2352x1568px.
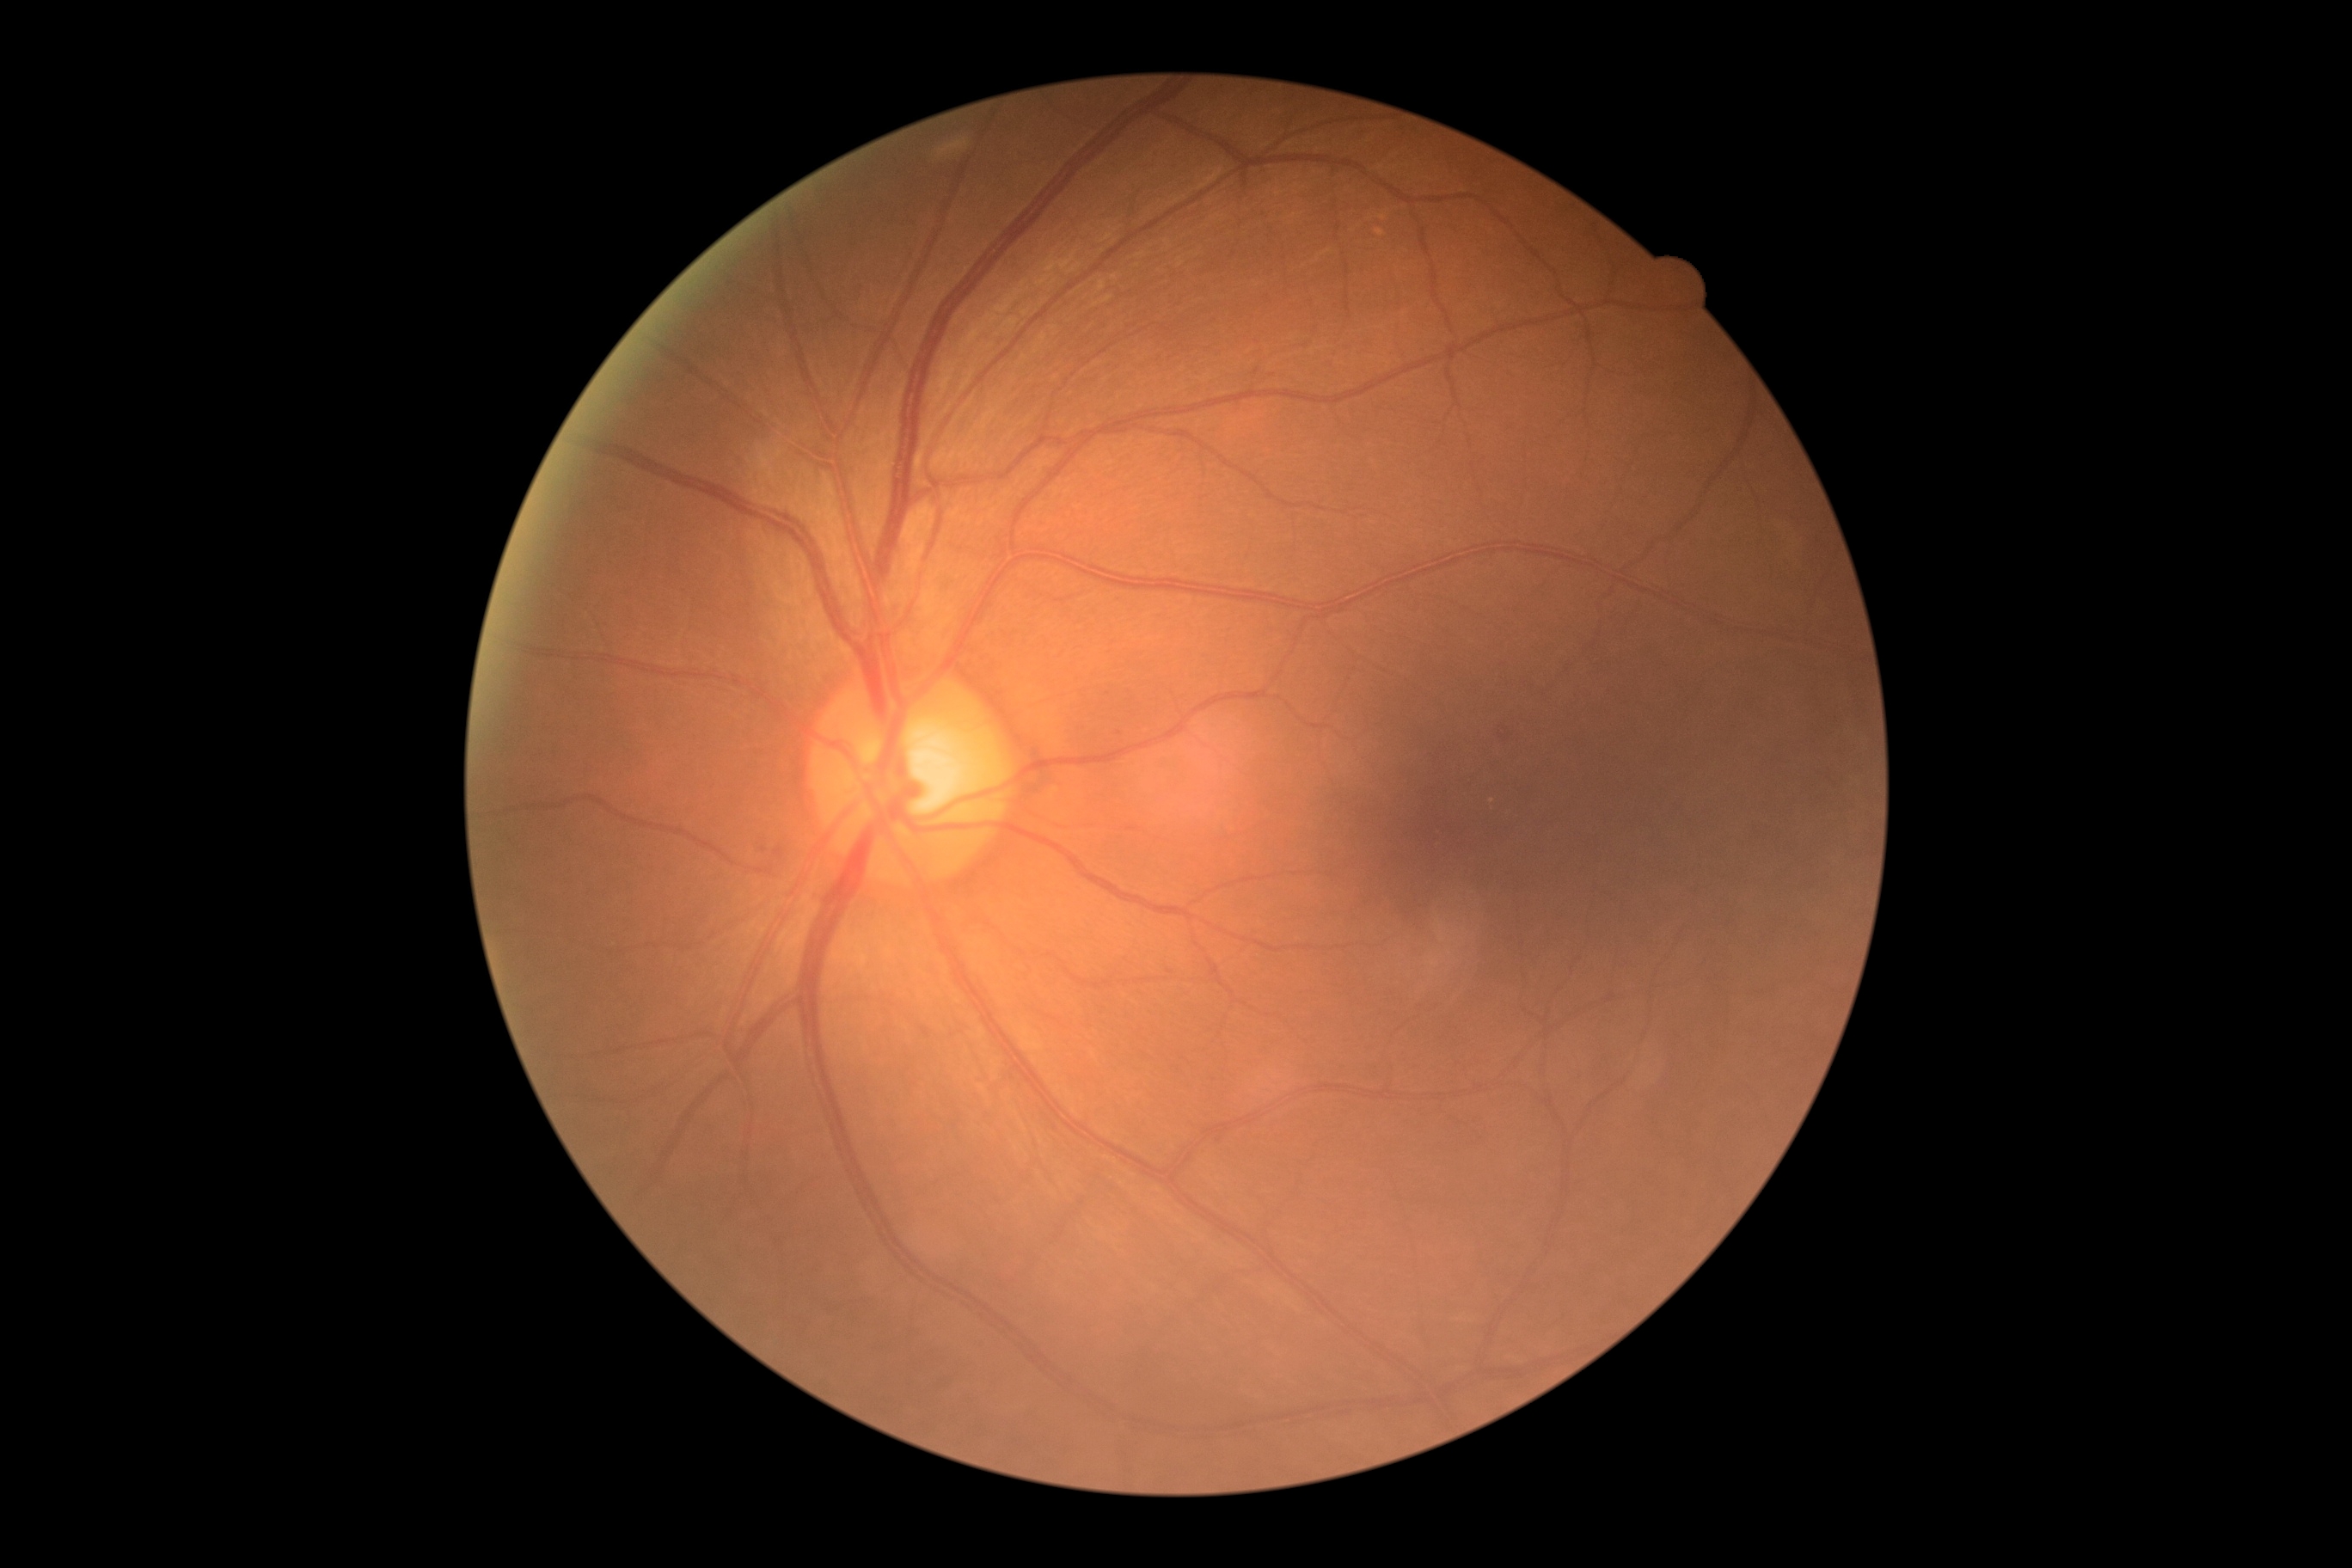
DR severity: moderate non-proliferative diabetic retinopathy (grade 2).